Image size 848x848 · modified Davis grading
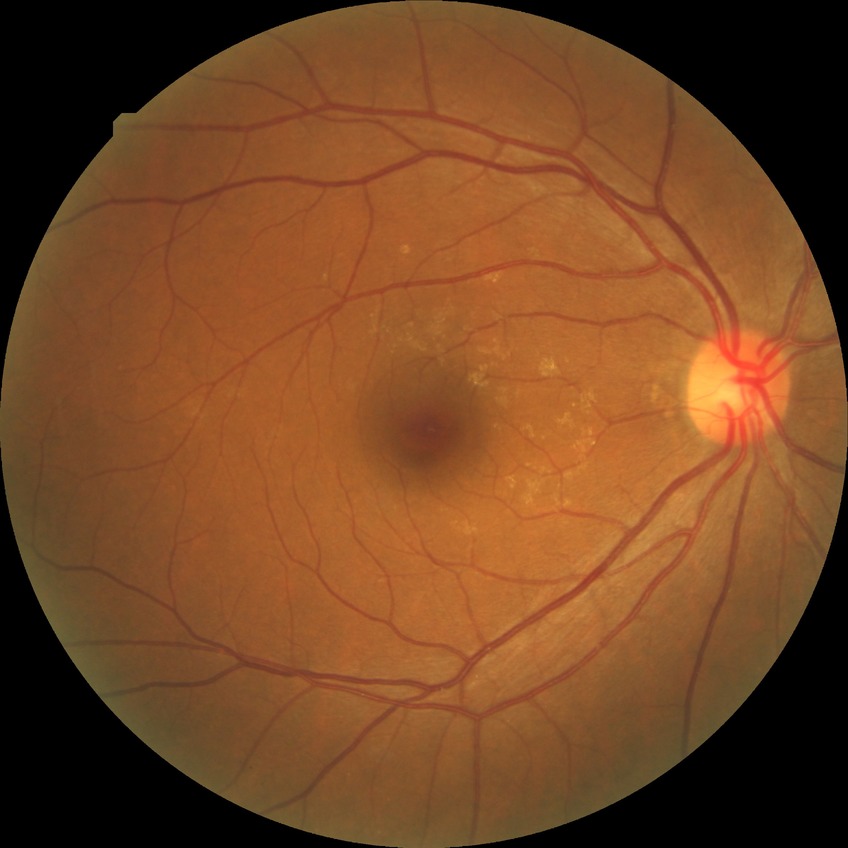

Davis stage=NDR, DR impression=negative for DR.